Nonmydriatic · 45° field of view · camera: NIDEK AFC-230 · image size 848x848 — 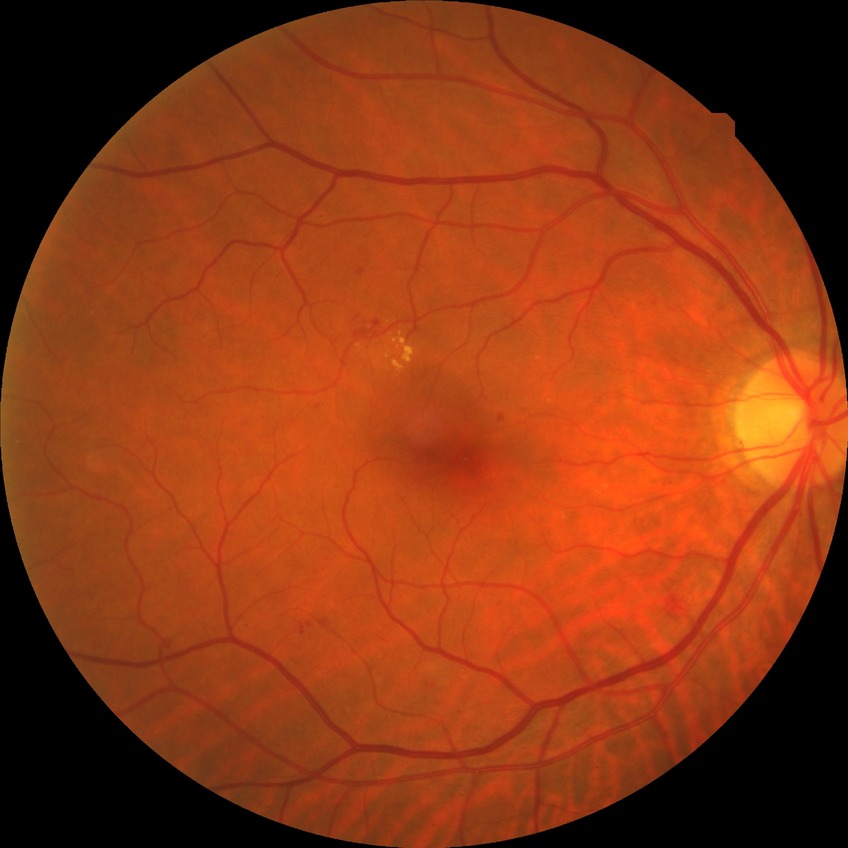
DR class = non-proliferative diabetic retinopathy; diabetic retinopathy (DR) = SDR (simple diabetic retinopathy).